45-degree field of view · 2212x1659px · retinal fundus photograph — 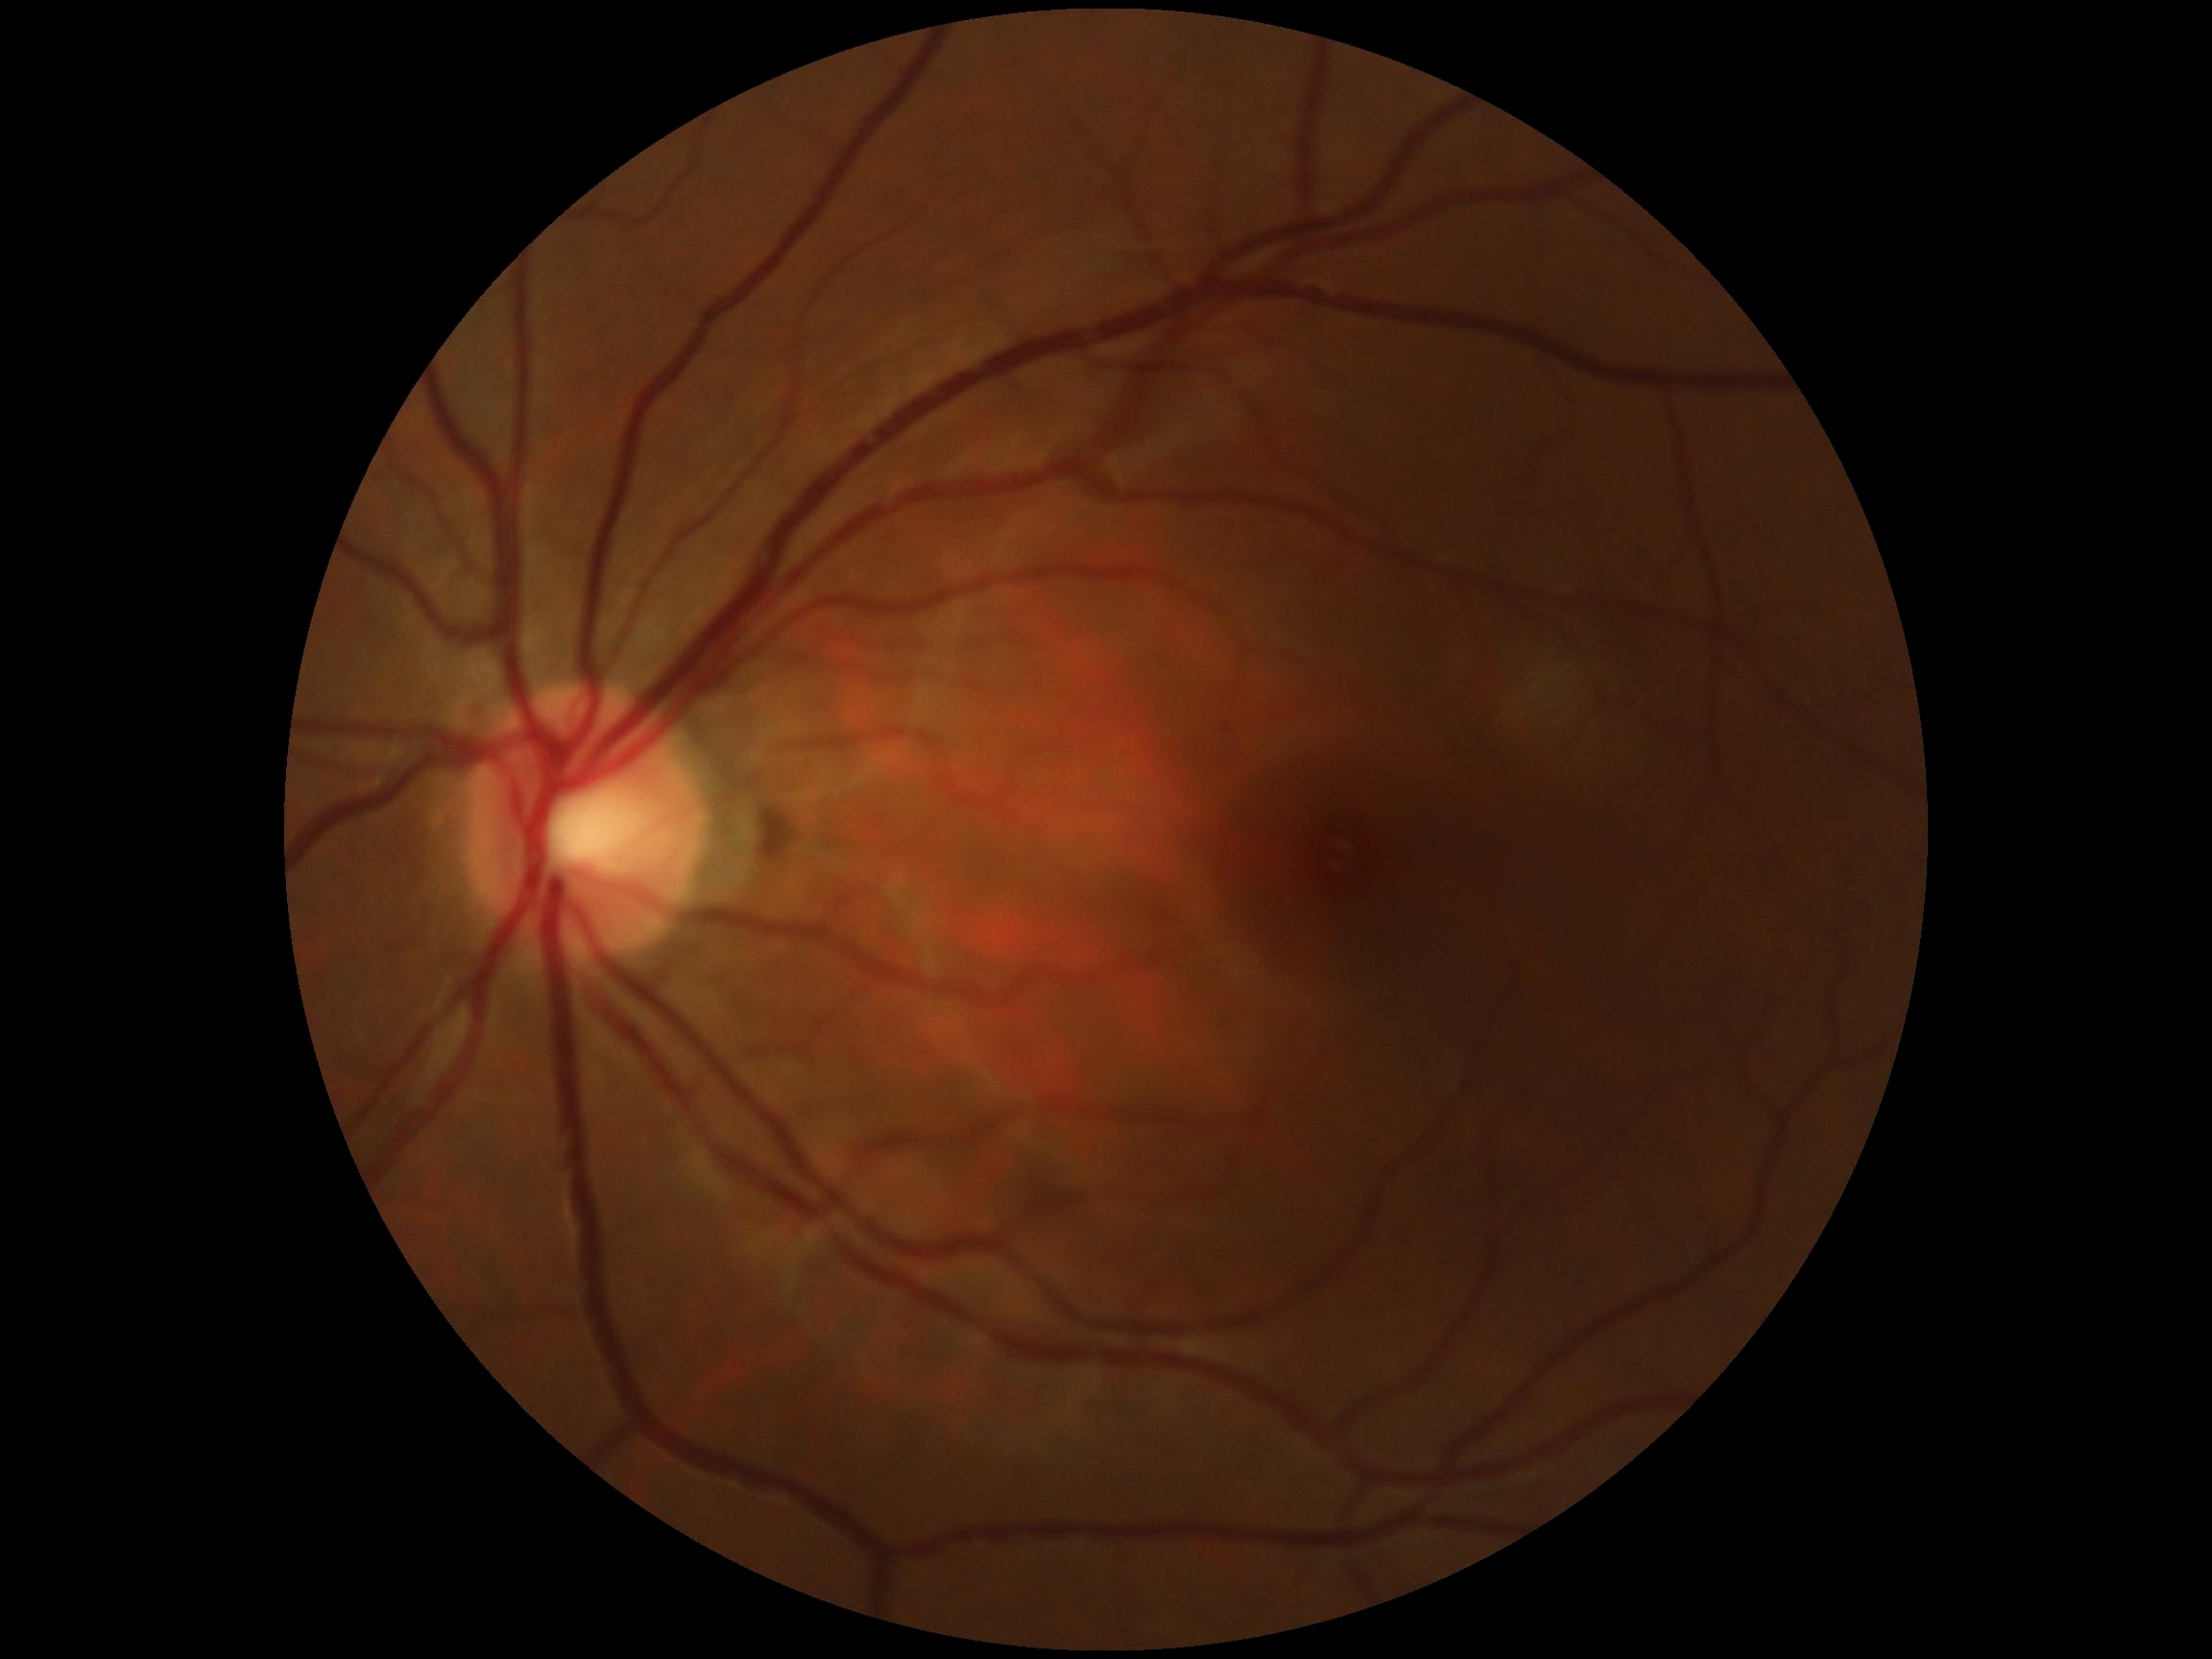
DR severity = grade 0 (no apparent retinopathy).